Image size 1932x1916; color fundus photograph; FOV: 45 degrees:
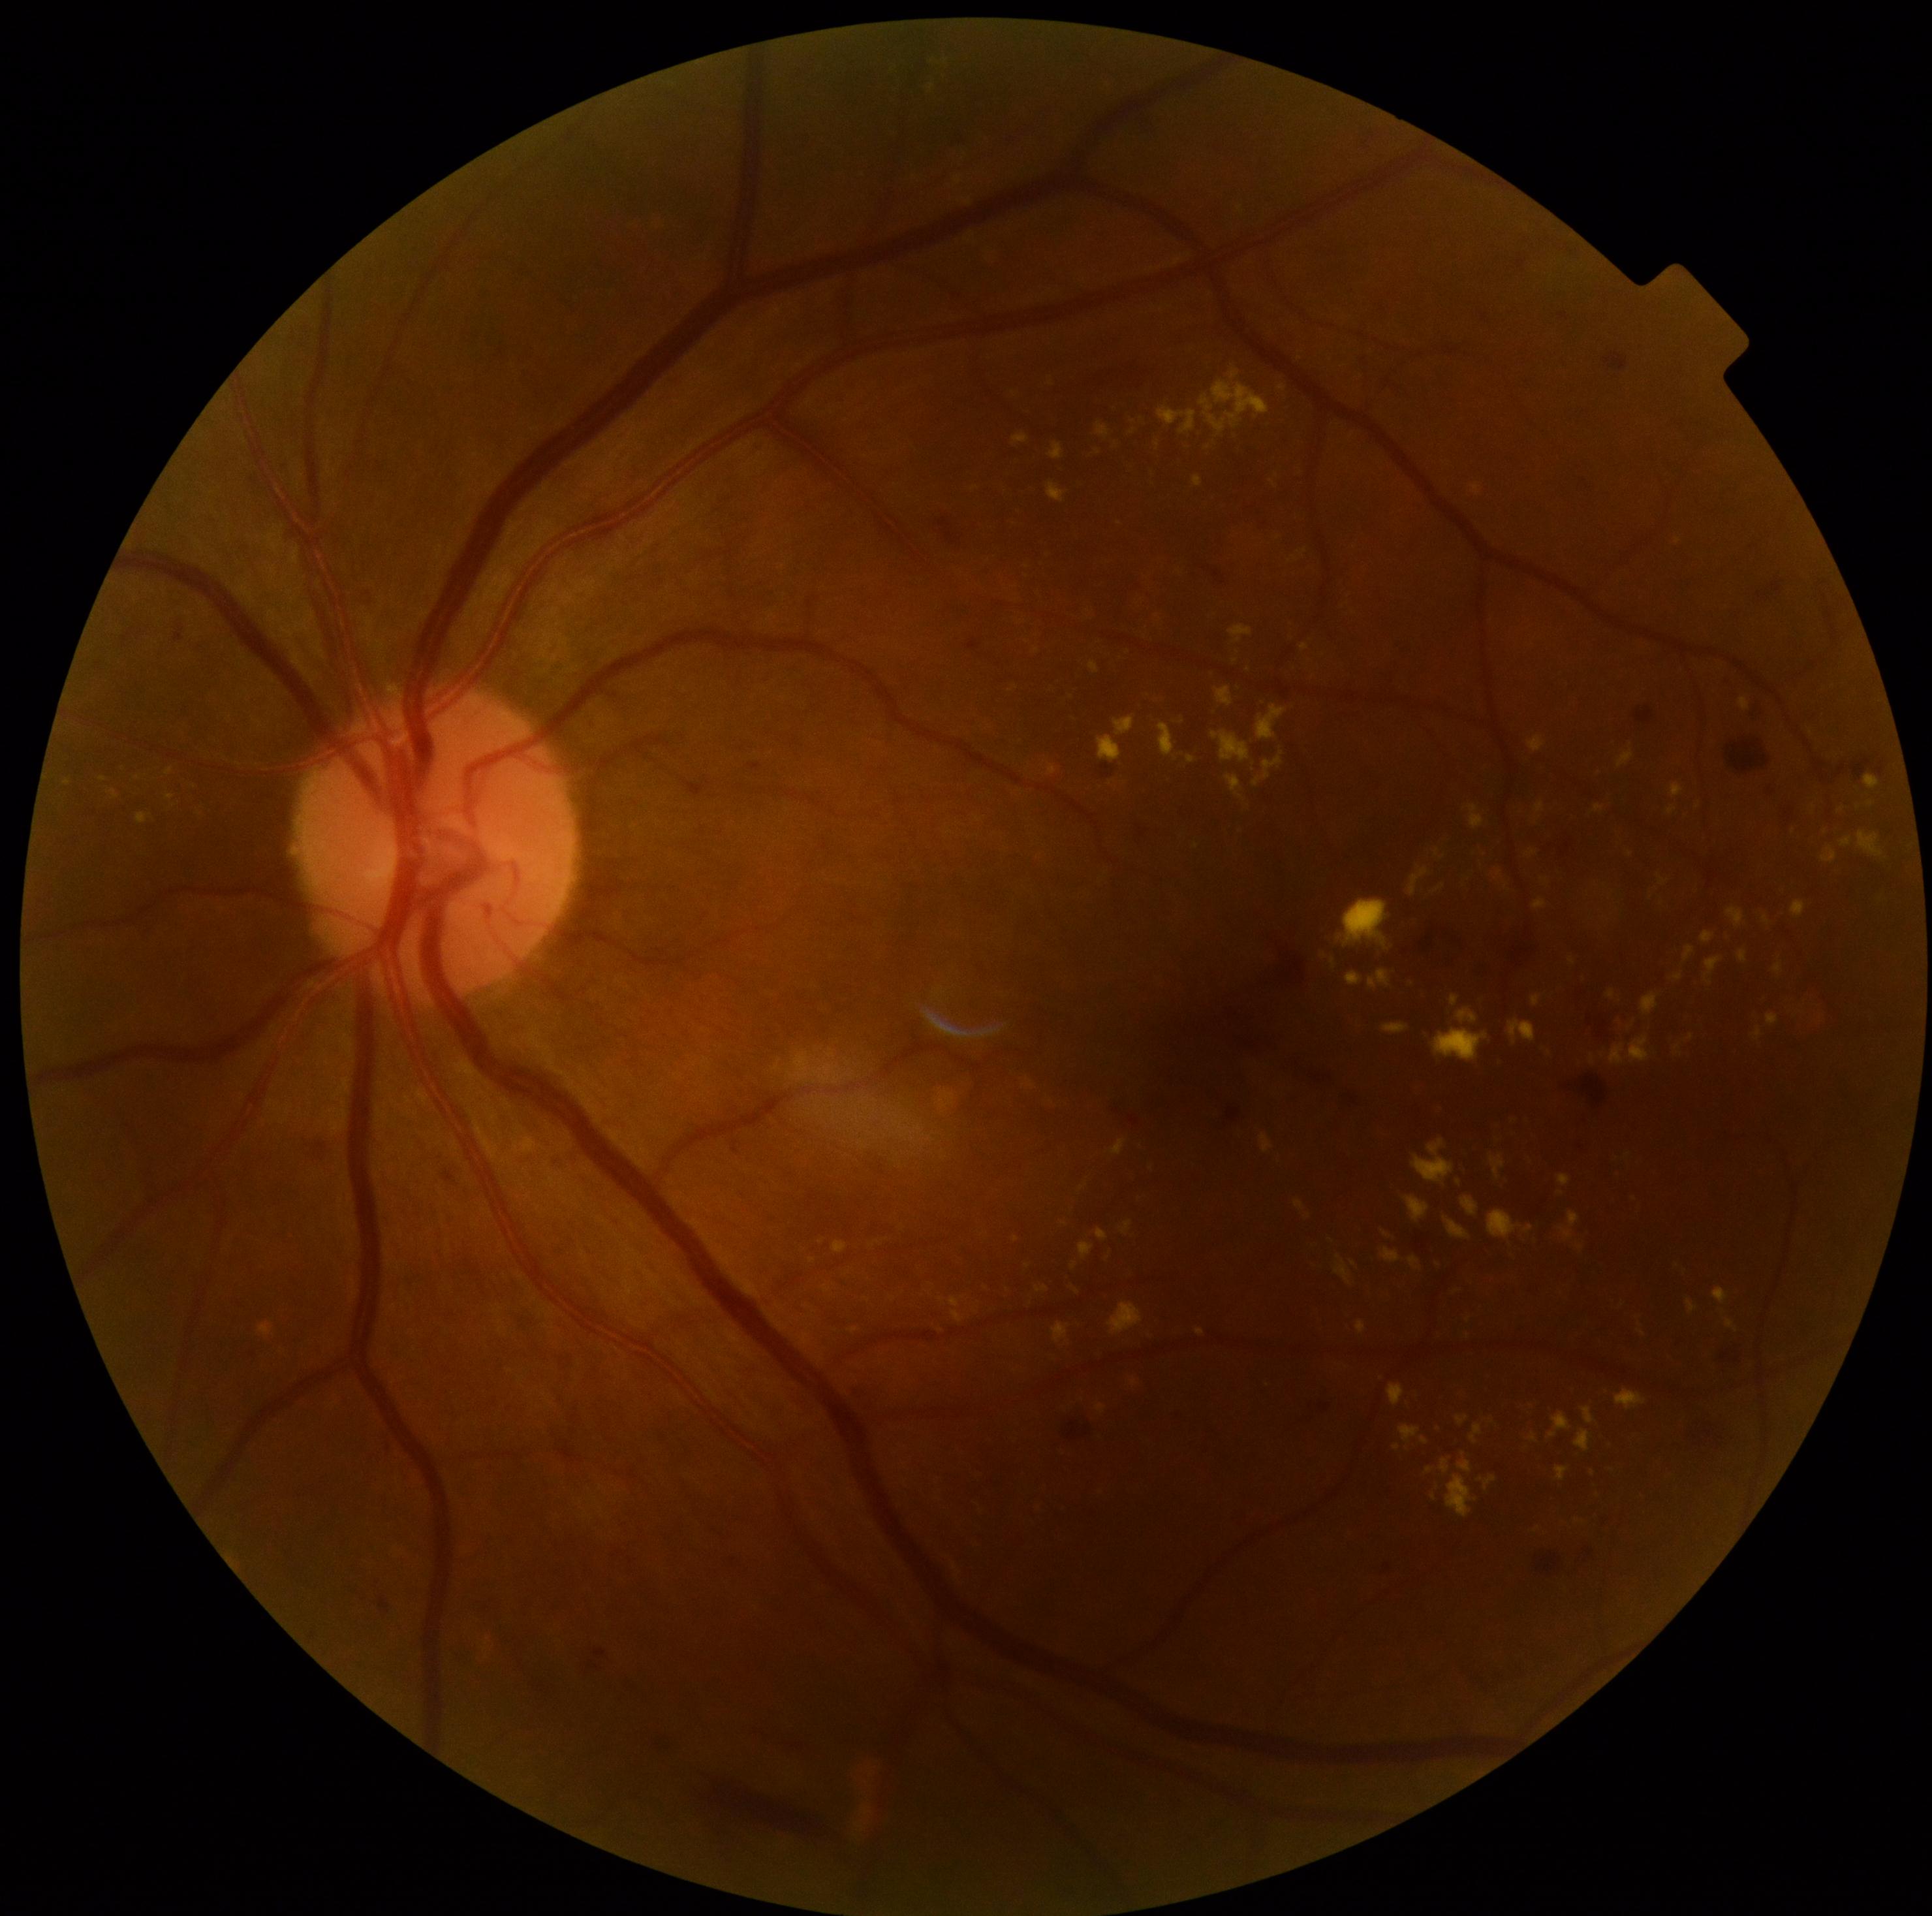
{"partial": true, "dr_grade": 2, "lesions": {"ex": [[1768, 1013, 1779, 1025], [1382, 1248, 1400, 1264], [1628, 1037, 1651, 1064], [834, 1242, 848, 1255], [1865, 776, 1882, 790], [1595, 804, 1604, 812], [1674, 1046, 1683, 1056], [1461, 1196, 1478, 1217], [809, 1257, 817, 1264], [1726, 907, 1746, 928], [1533, 898, 1548, 909], [1109, 1303, 1143, 1336]], "ex_small_centers": [[1562, 1193], [1573, 961], [1538, 1529], [1794, 831], [1628, 1156], [1132, 433]]}}